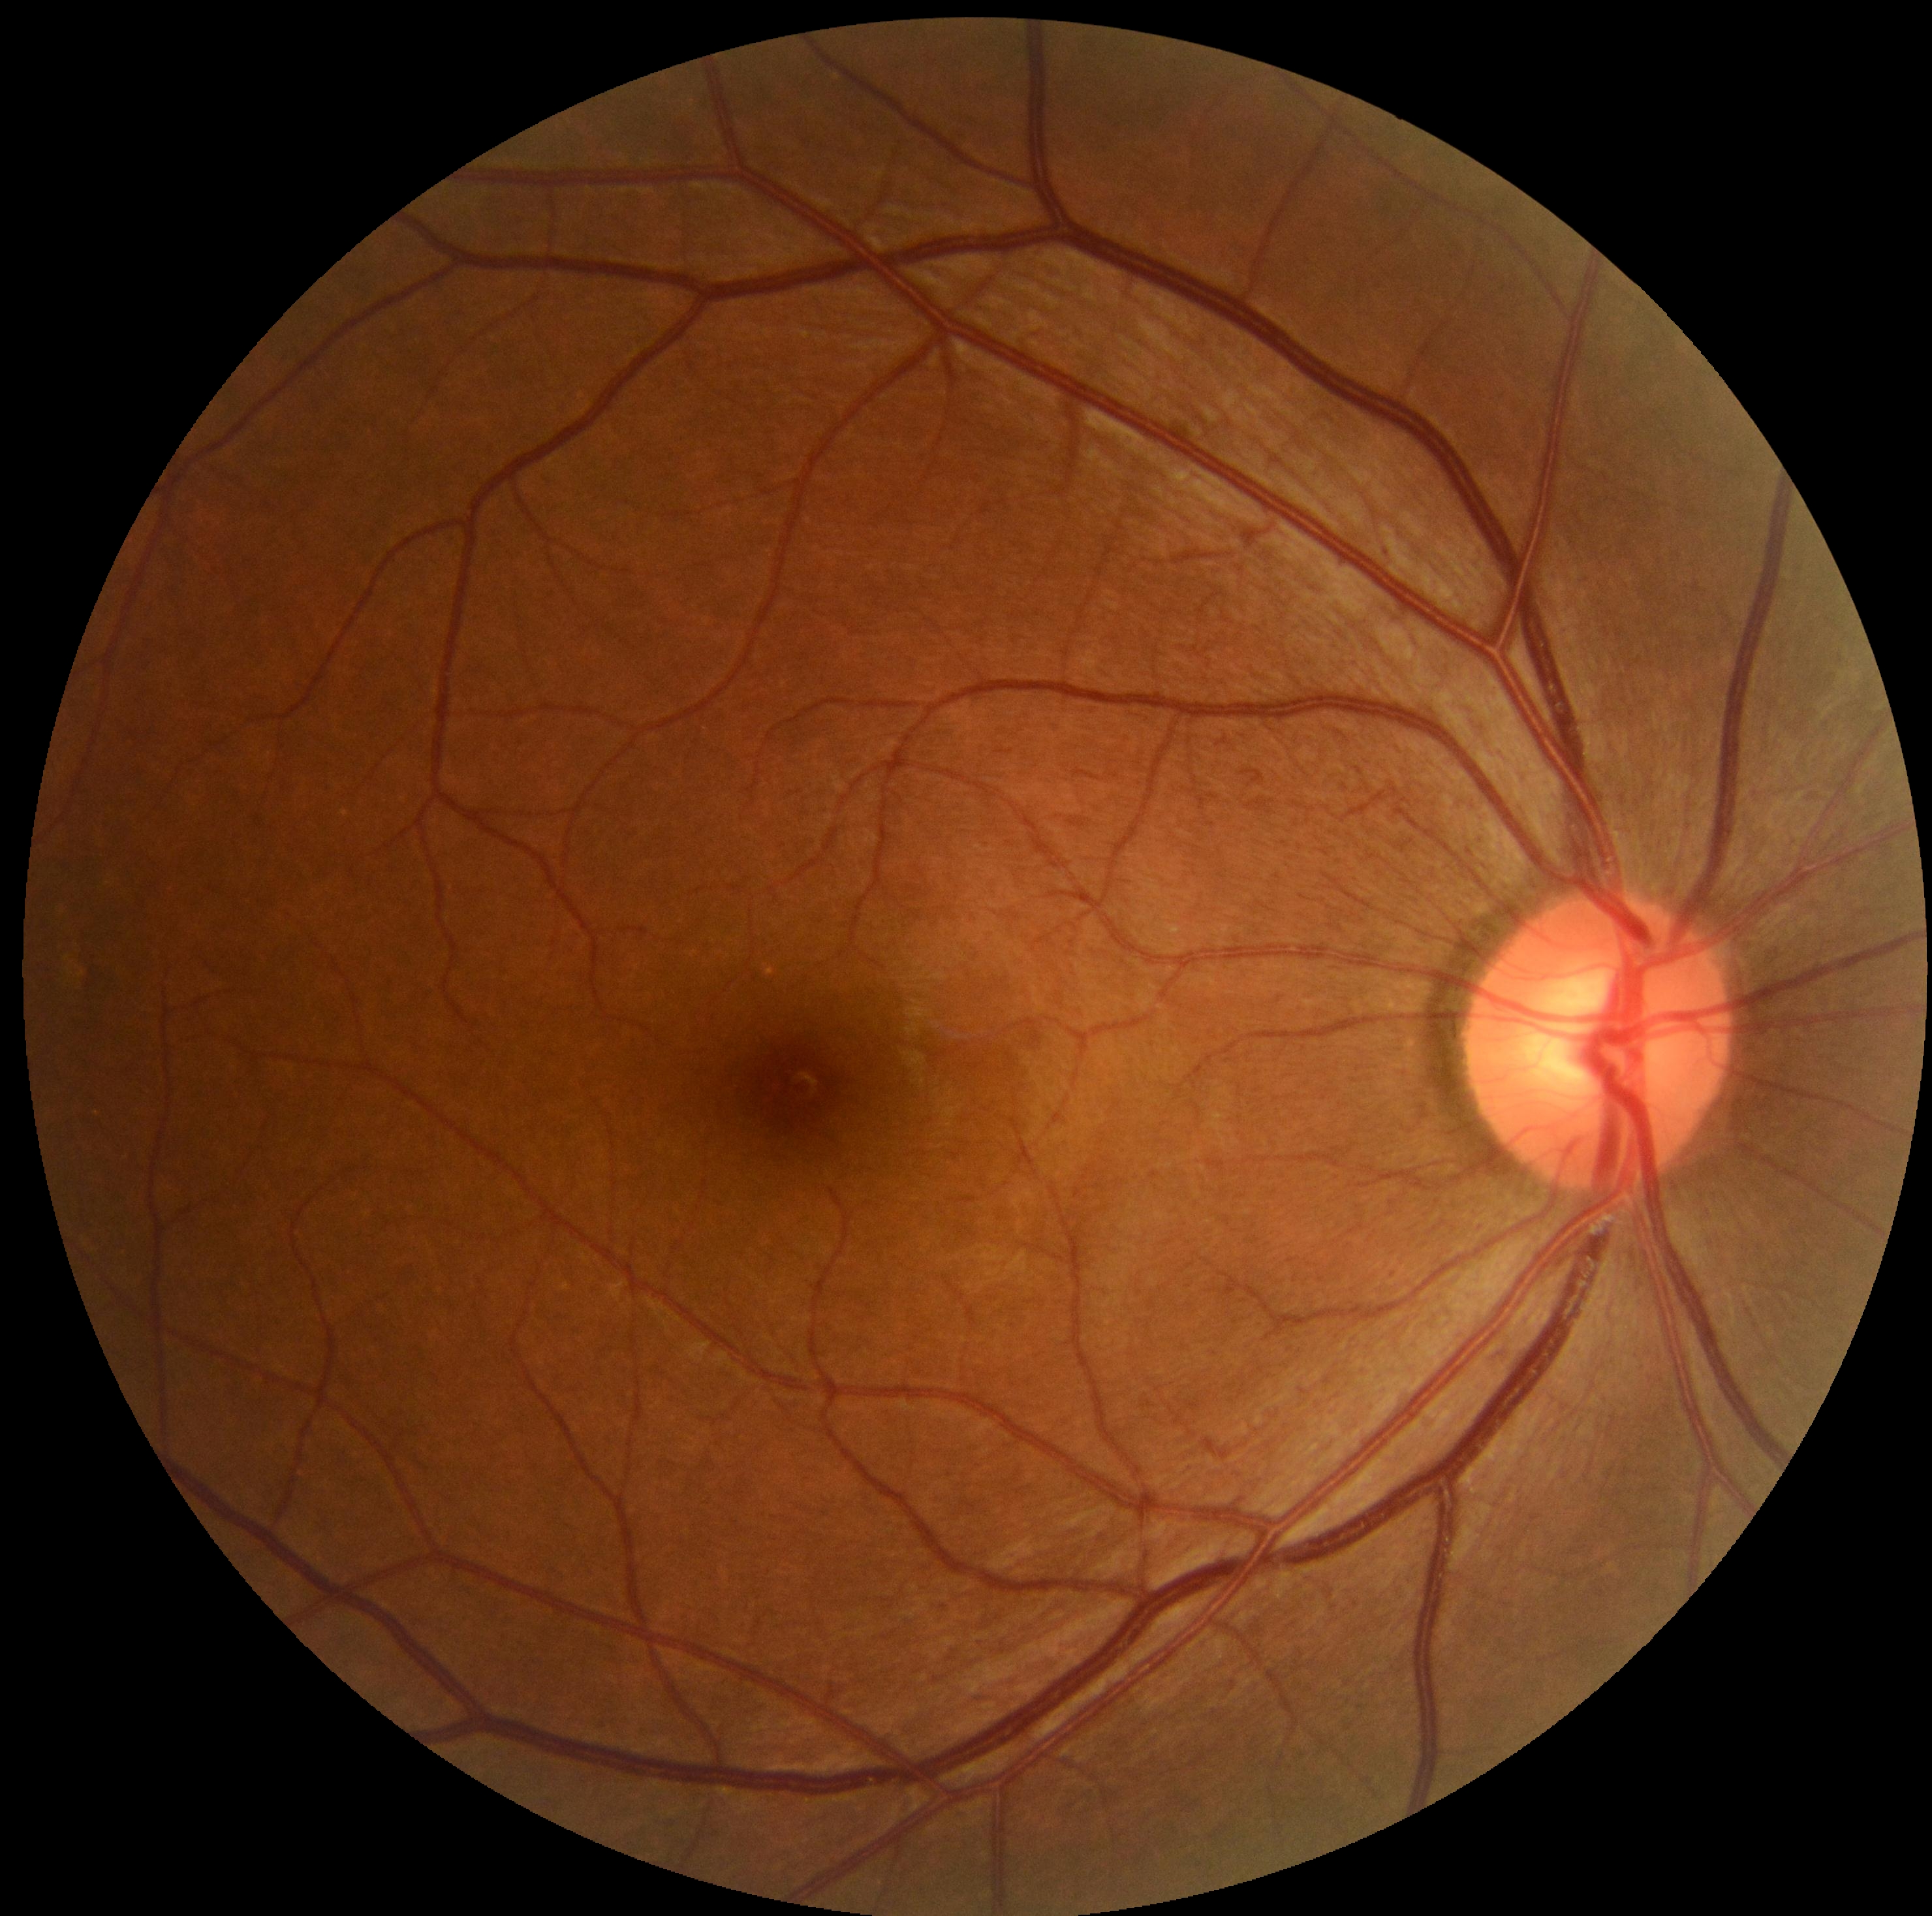
Annotations:
• DR stage — grade 0 (no apparent retinopathy)